FOV: 45 degrees — 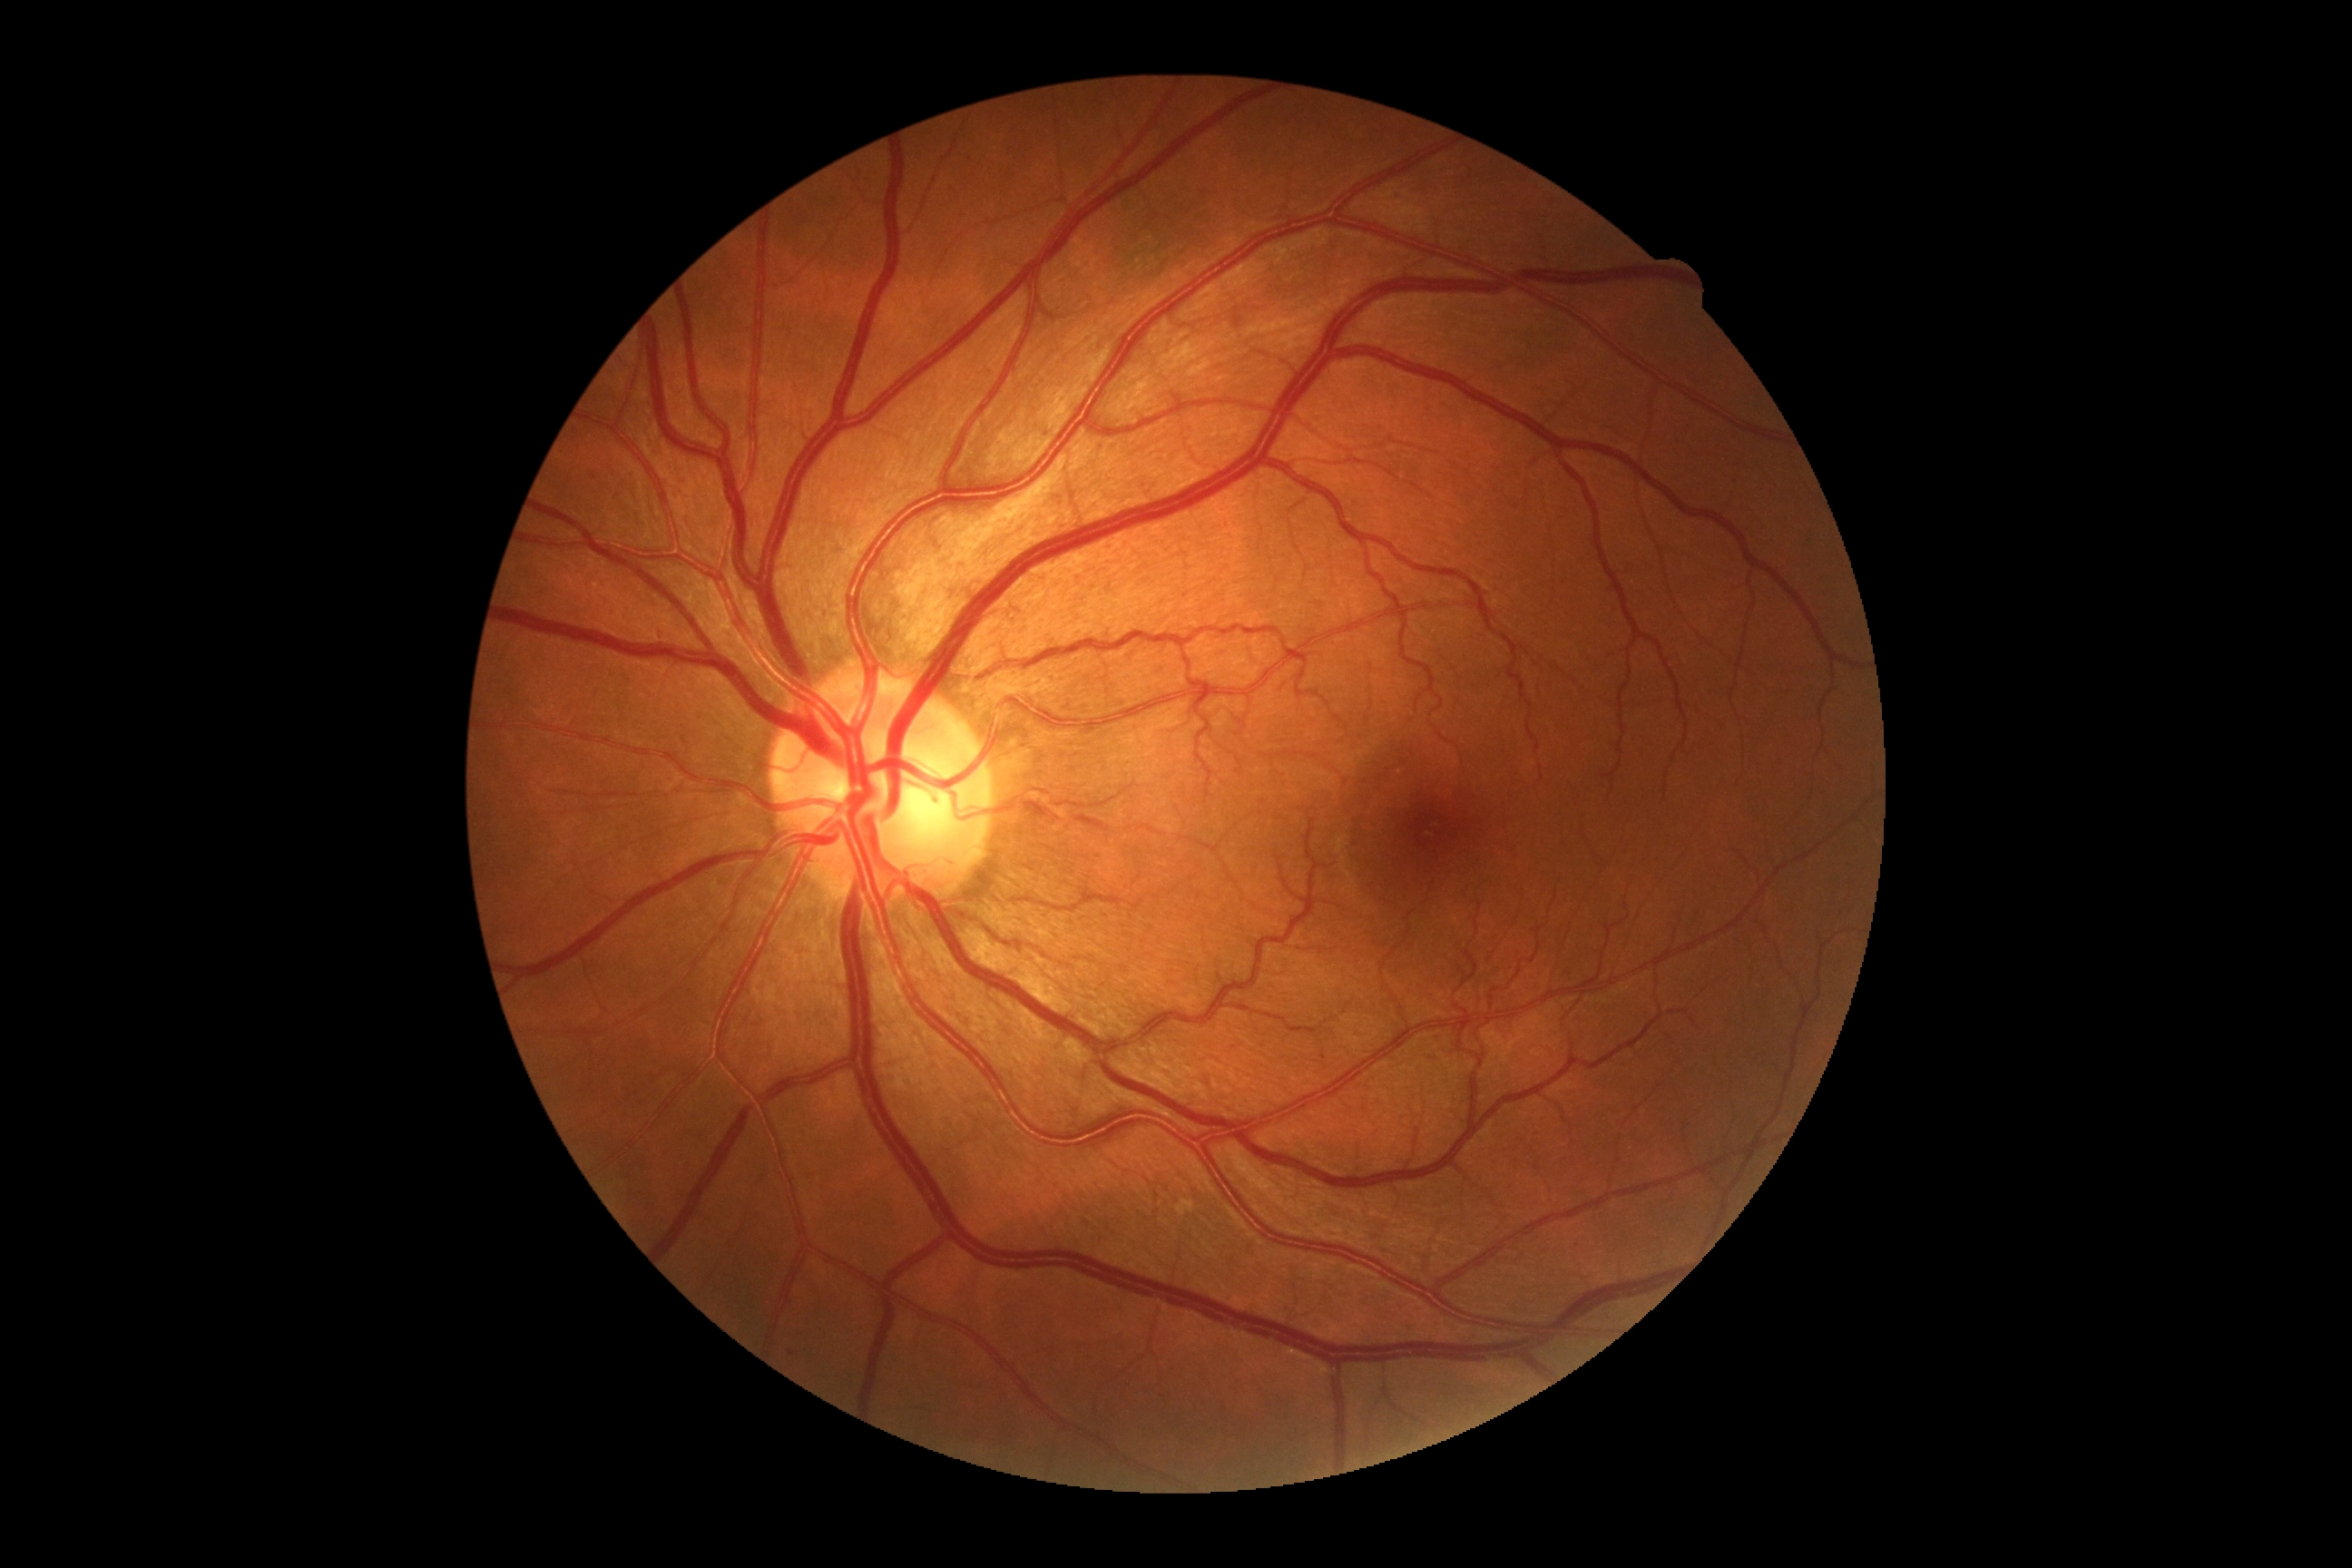 Diabetic retinopathy: no apparent retinopathy (grade 0).